45° field of view.
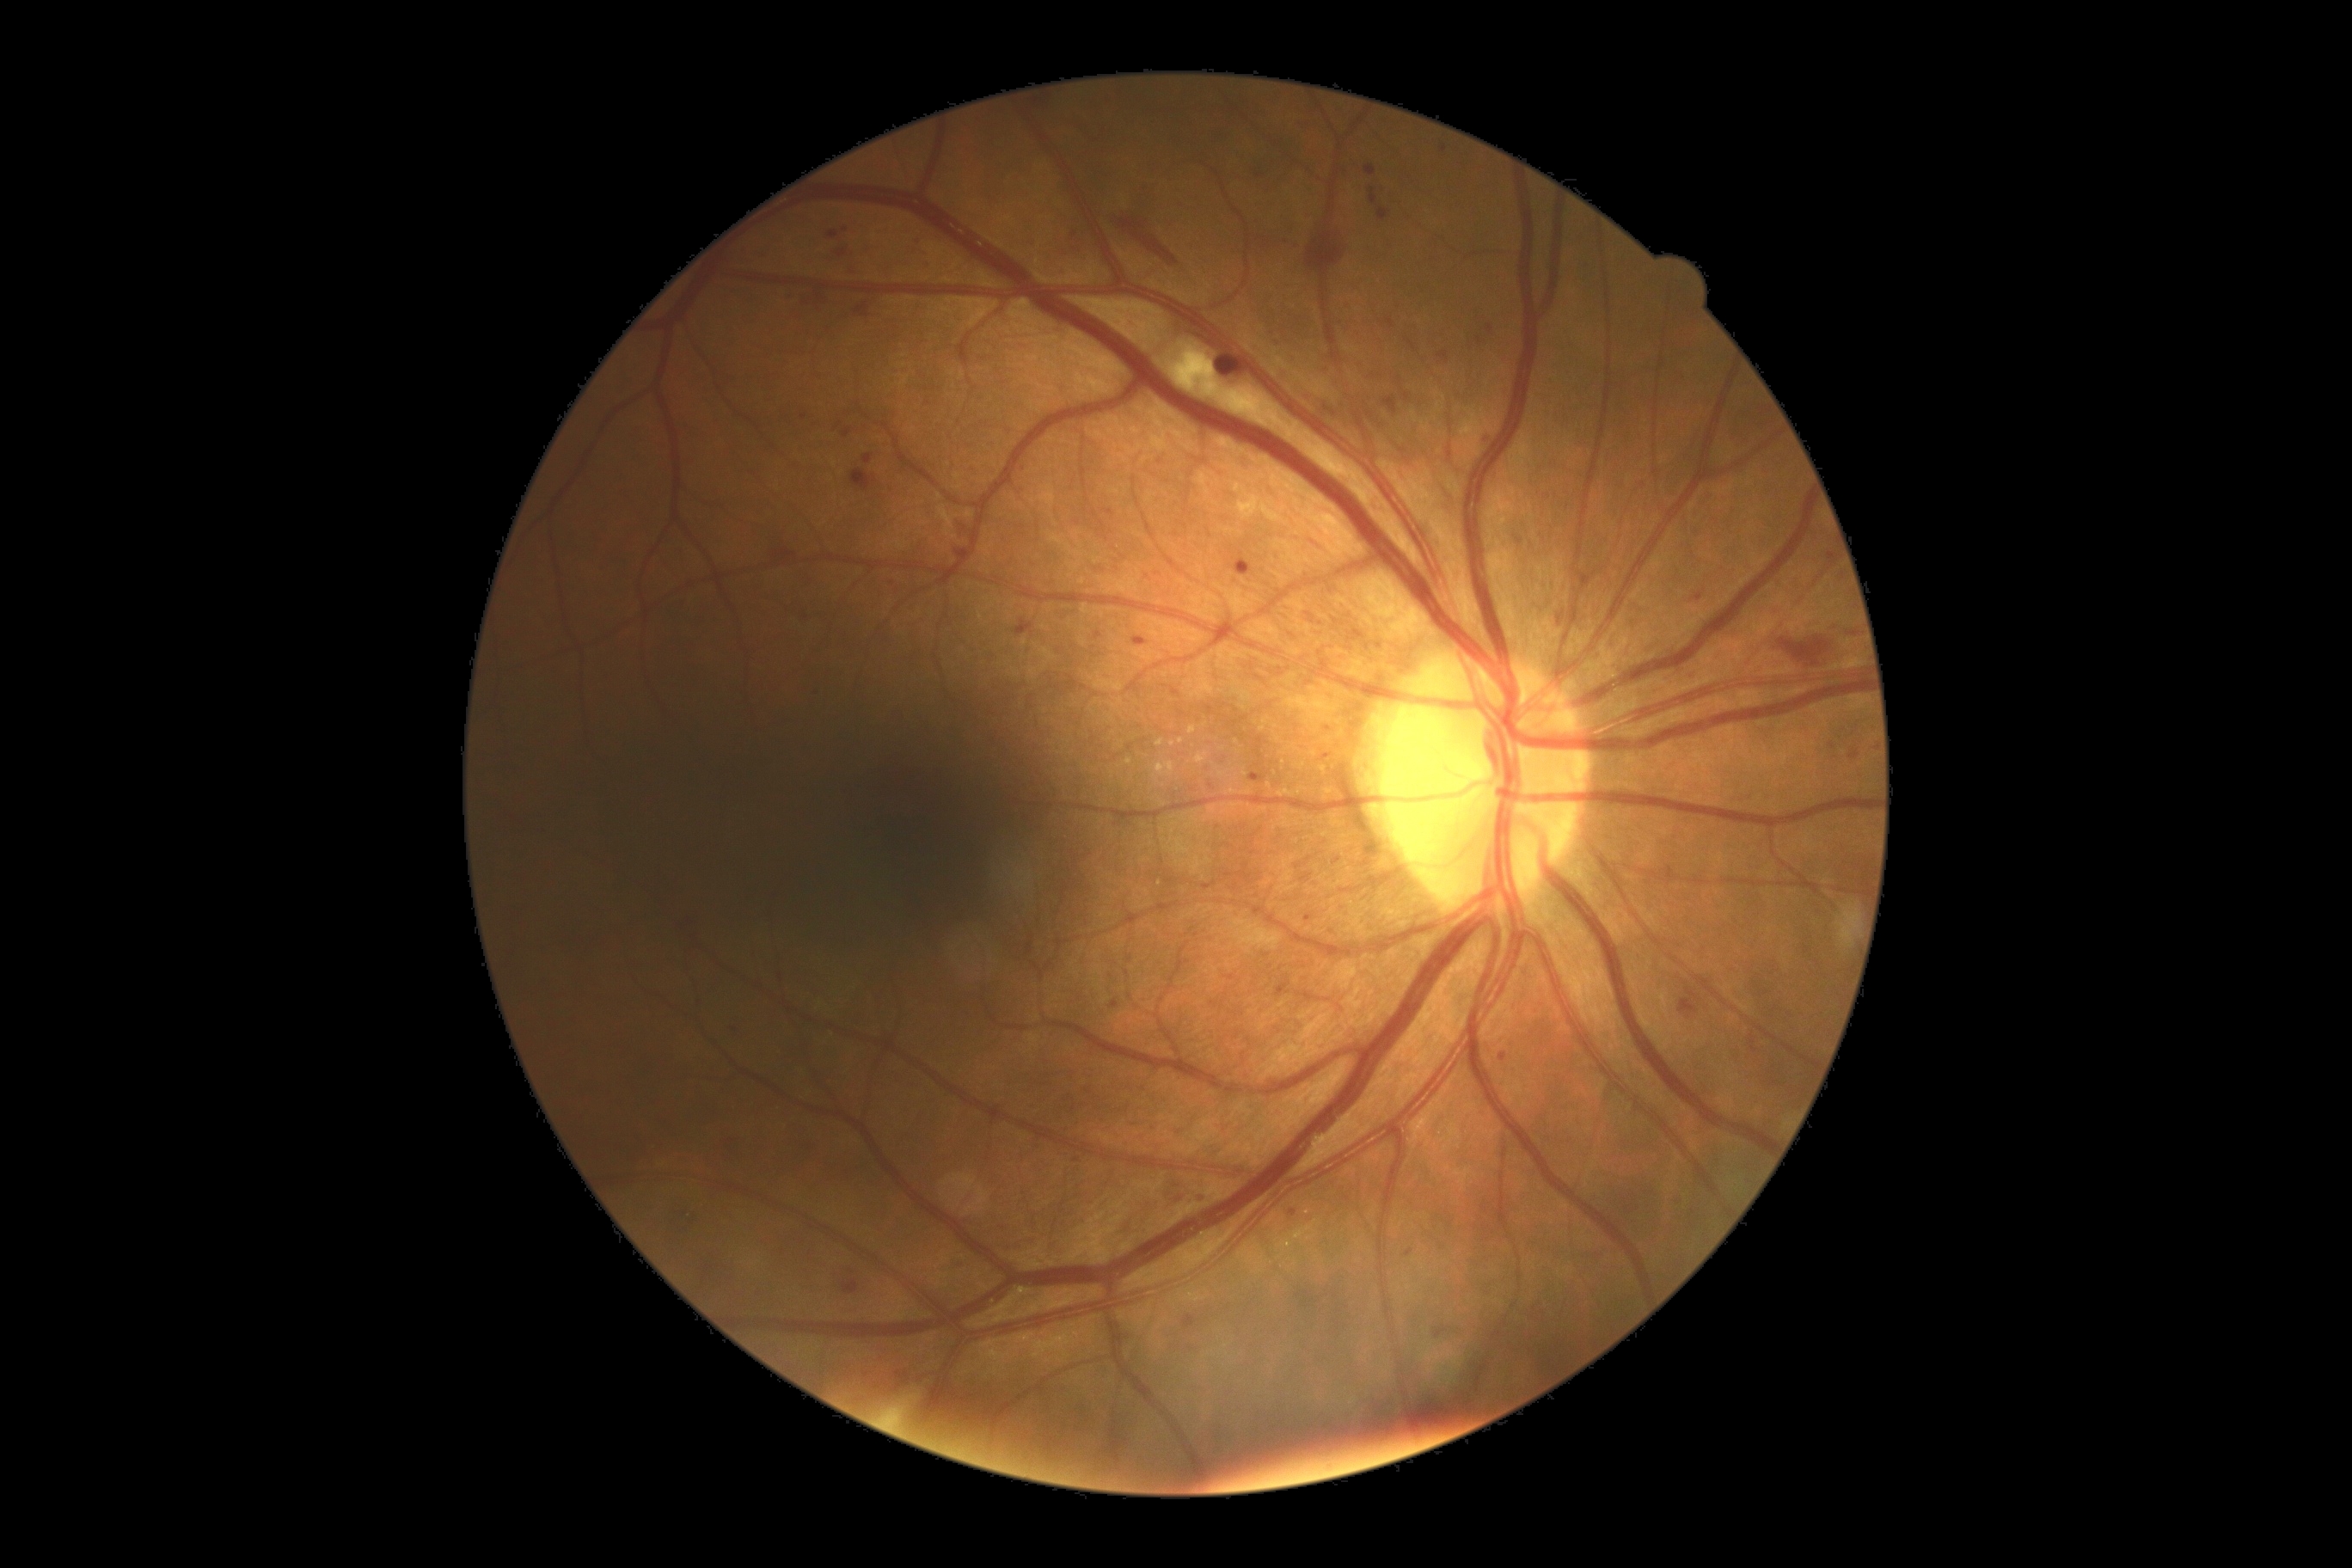

Diabetic retinopathy is 2/4 — more than just microaneurysms but less than severe NPDR.
DR class: non-proliferative diabetic retinopathy.